45° FOV. 848 x 848 pixels. Nonmydriatic fundus photograph. NIDEK AFC-230 fundus camera — 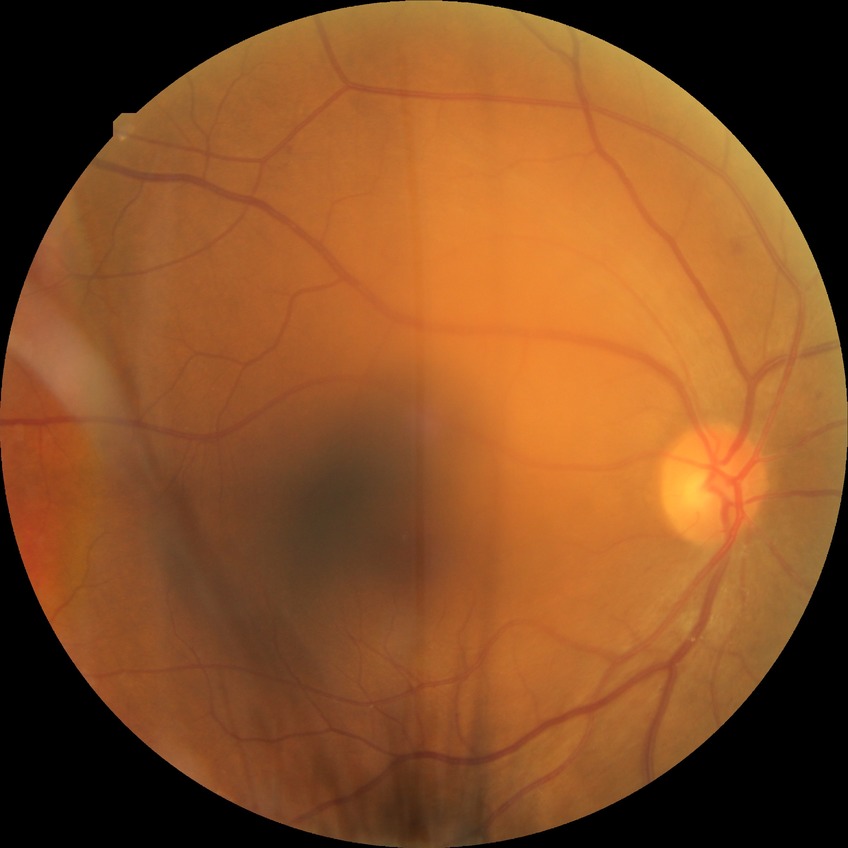
{
  "davis_grade": "simple diabetic retinopathy"
}